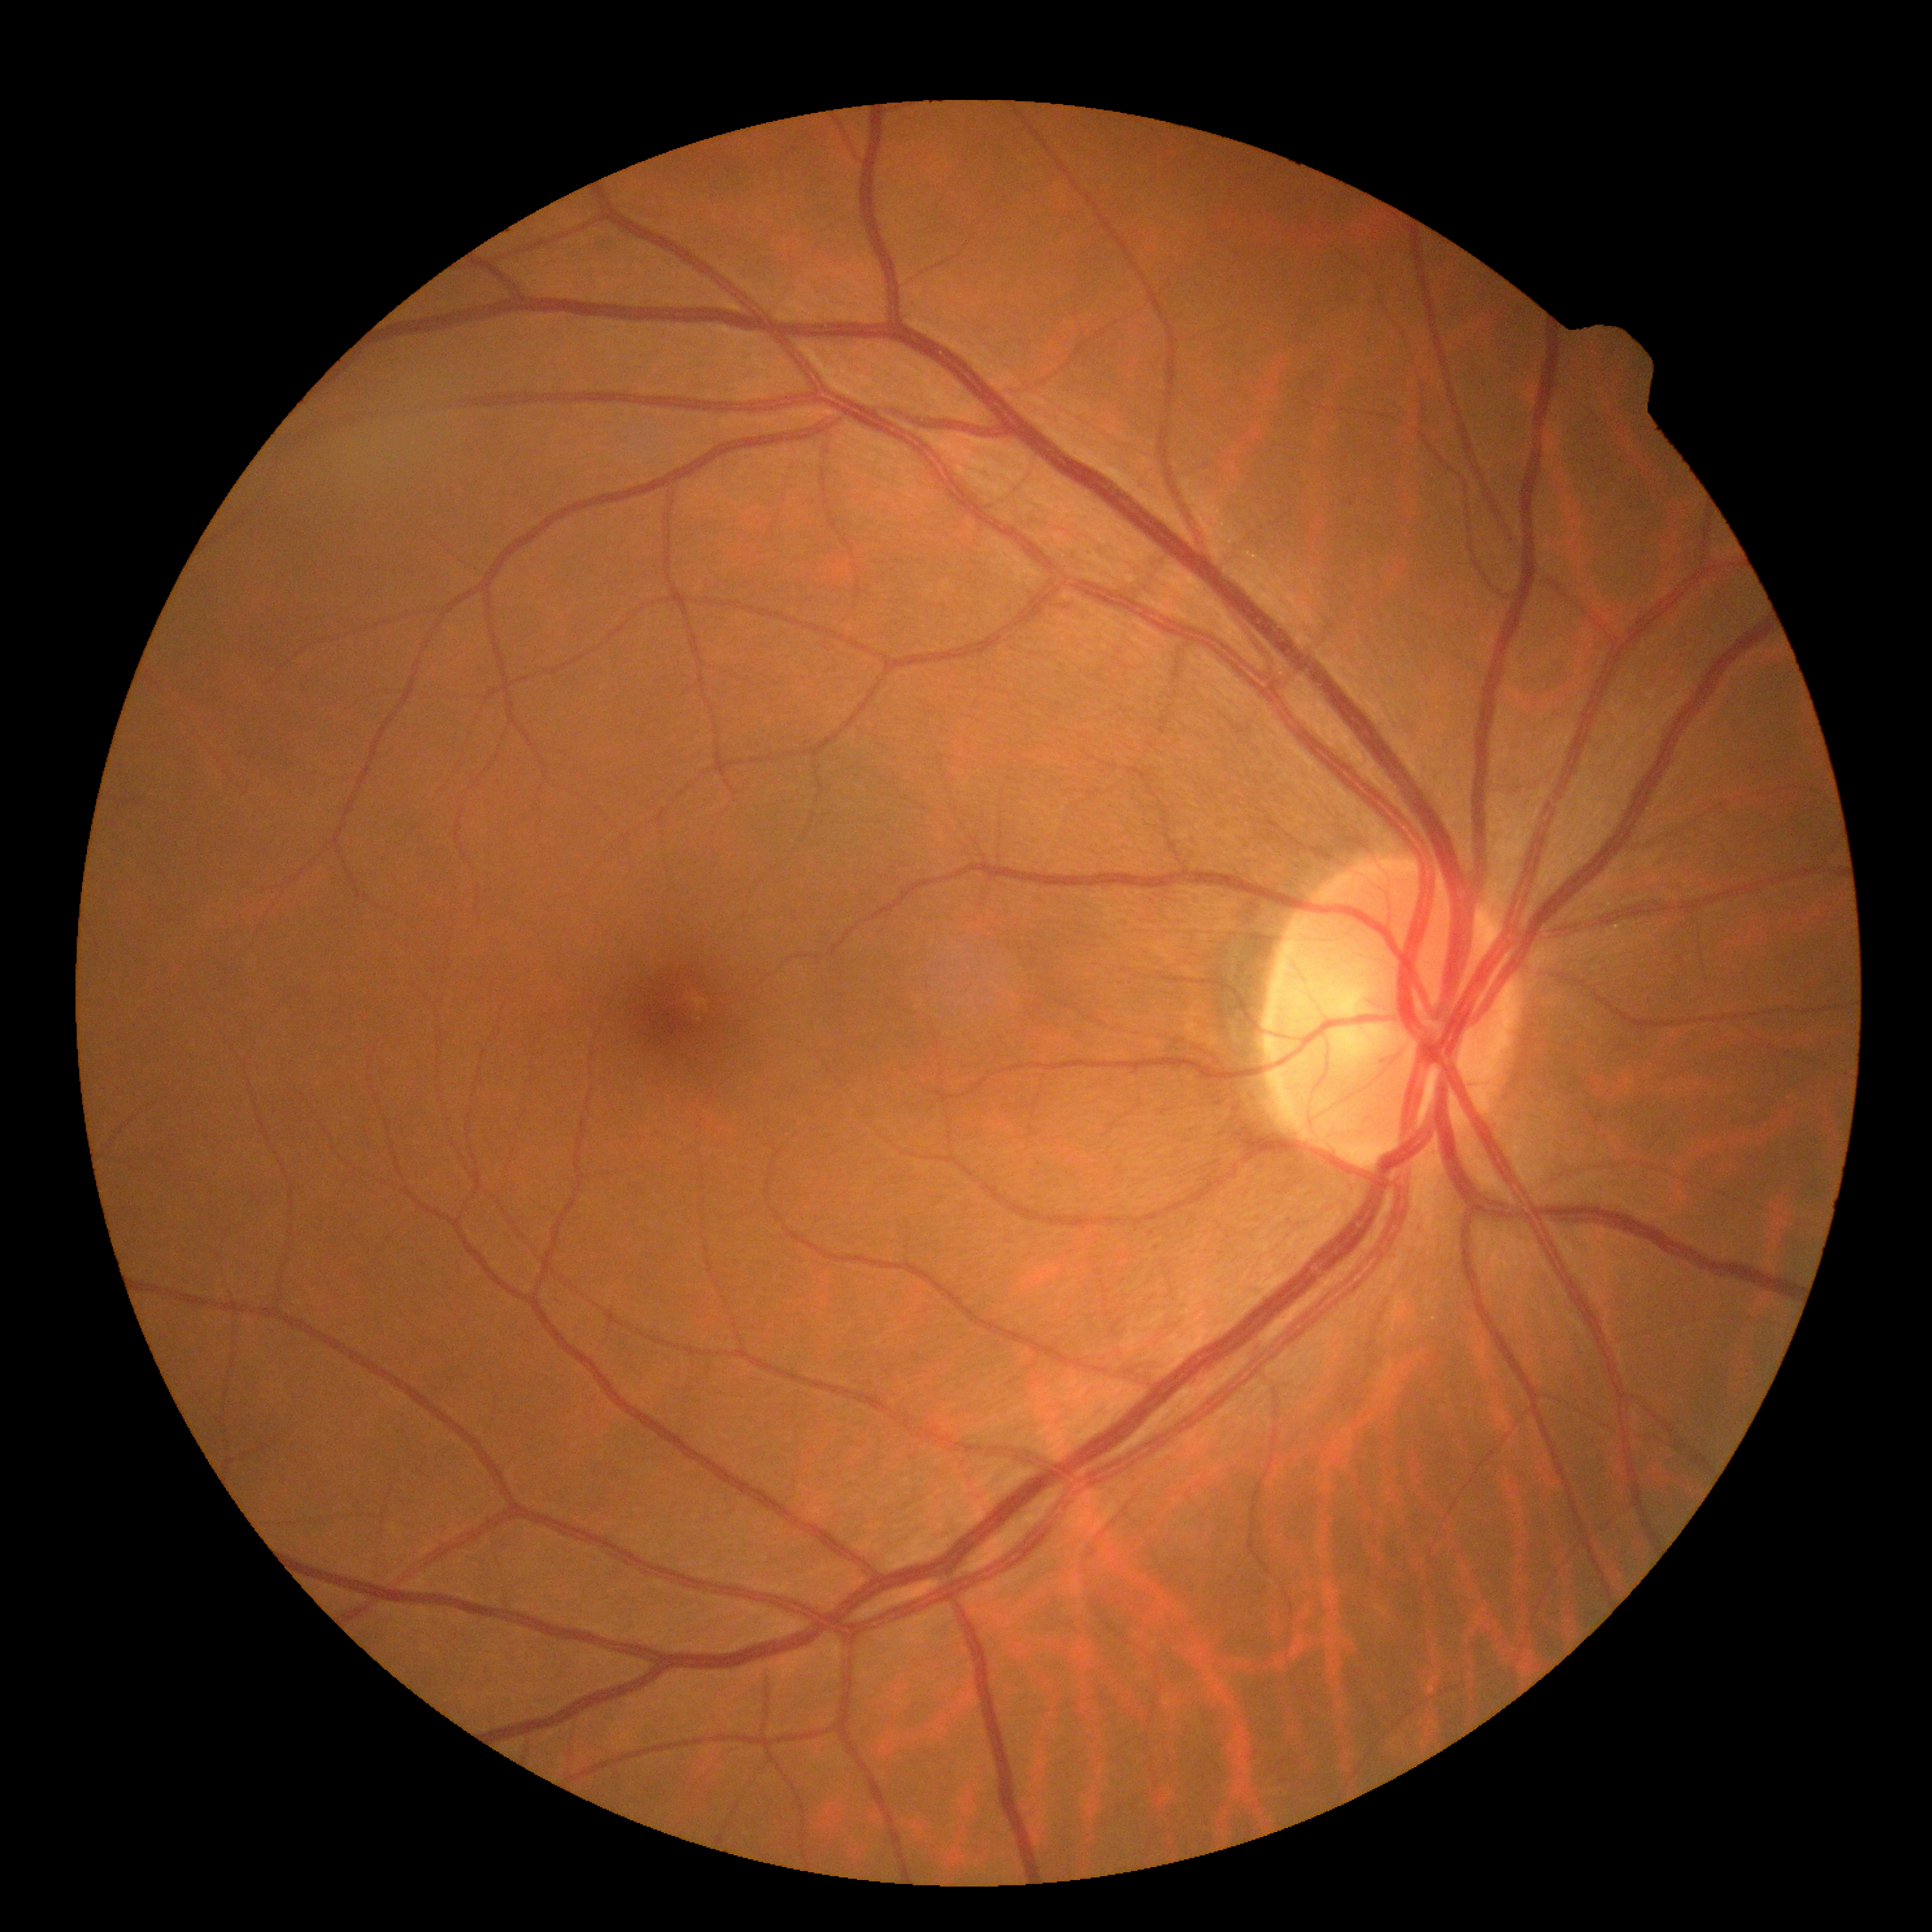 DR grade: 0.
No DR findings.